2048x1536 · CFP · 45° FOV:
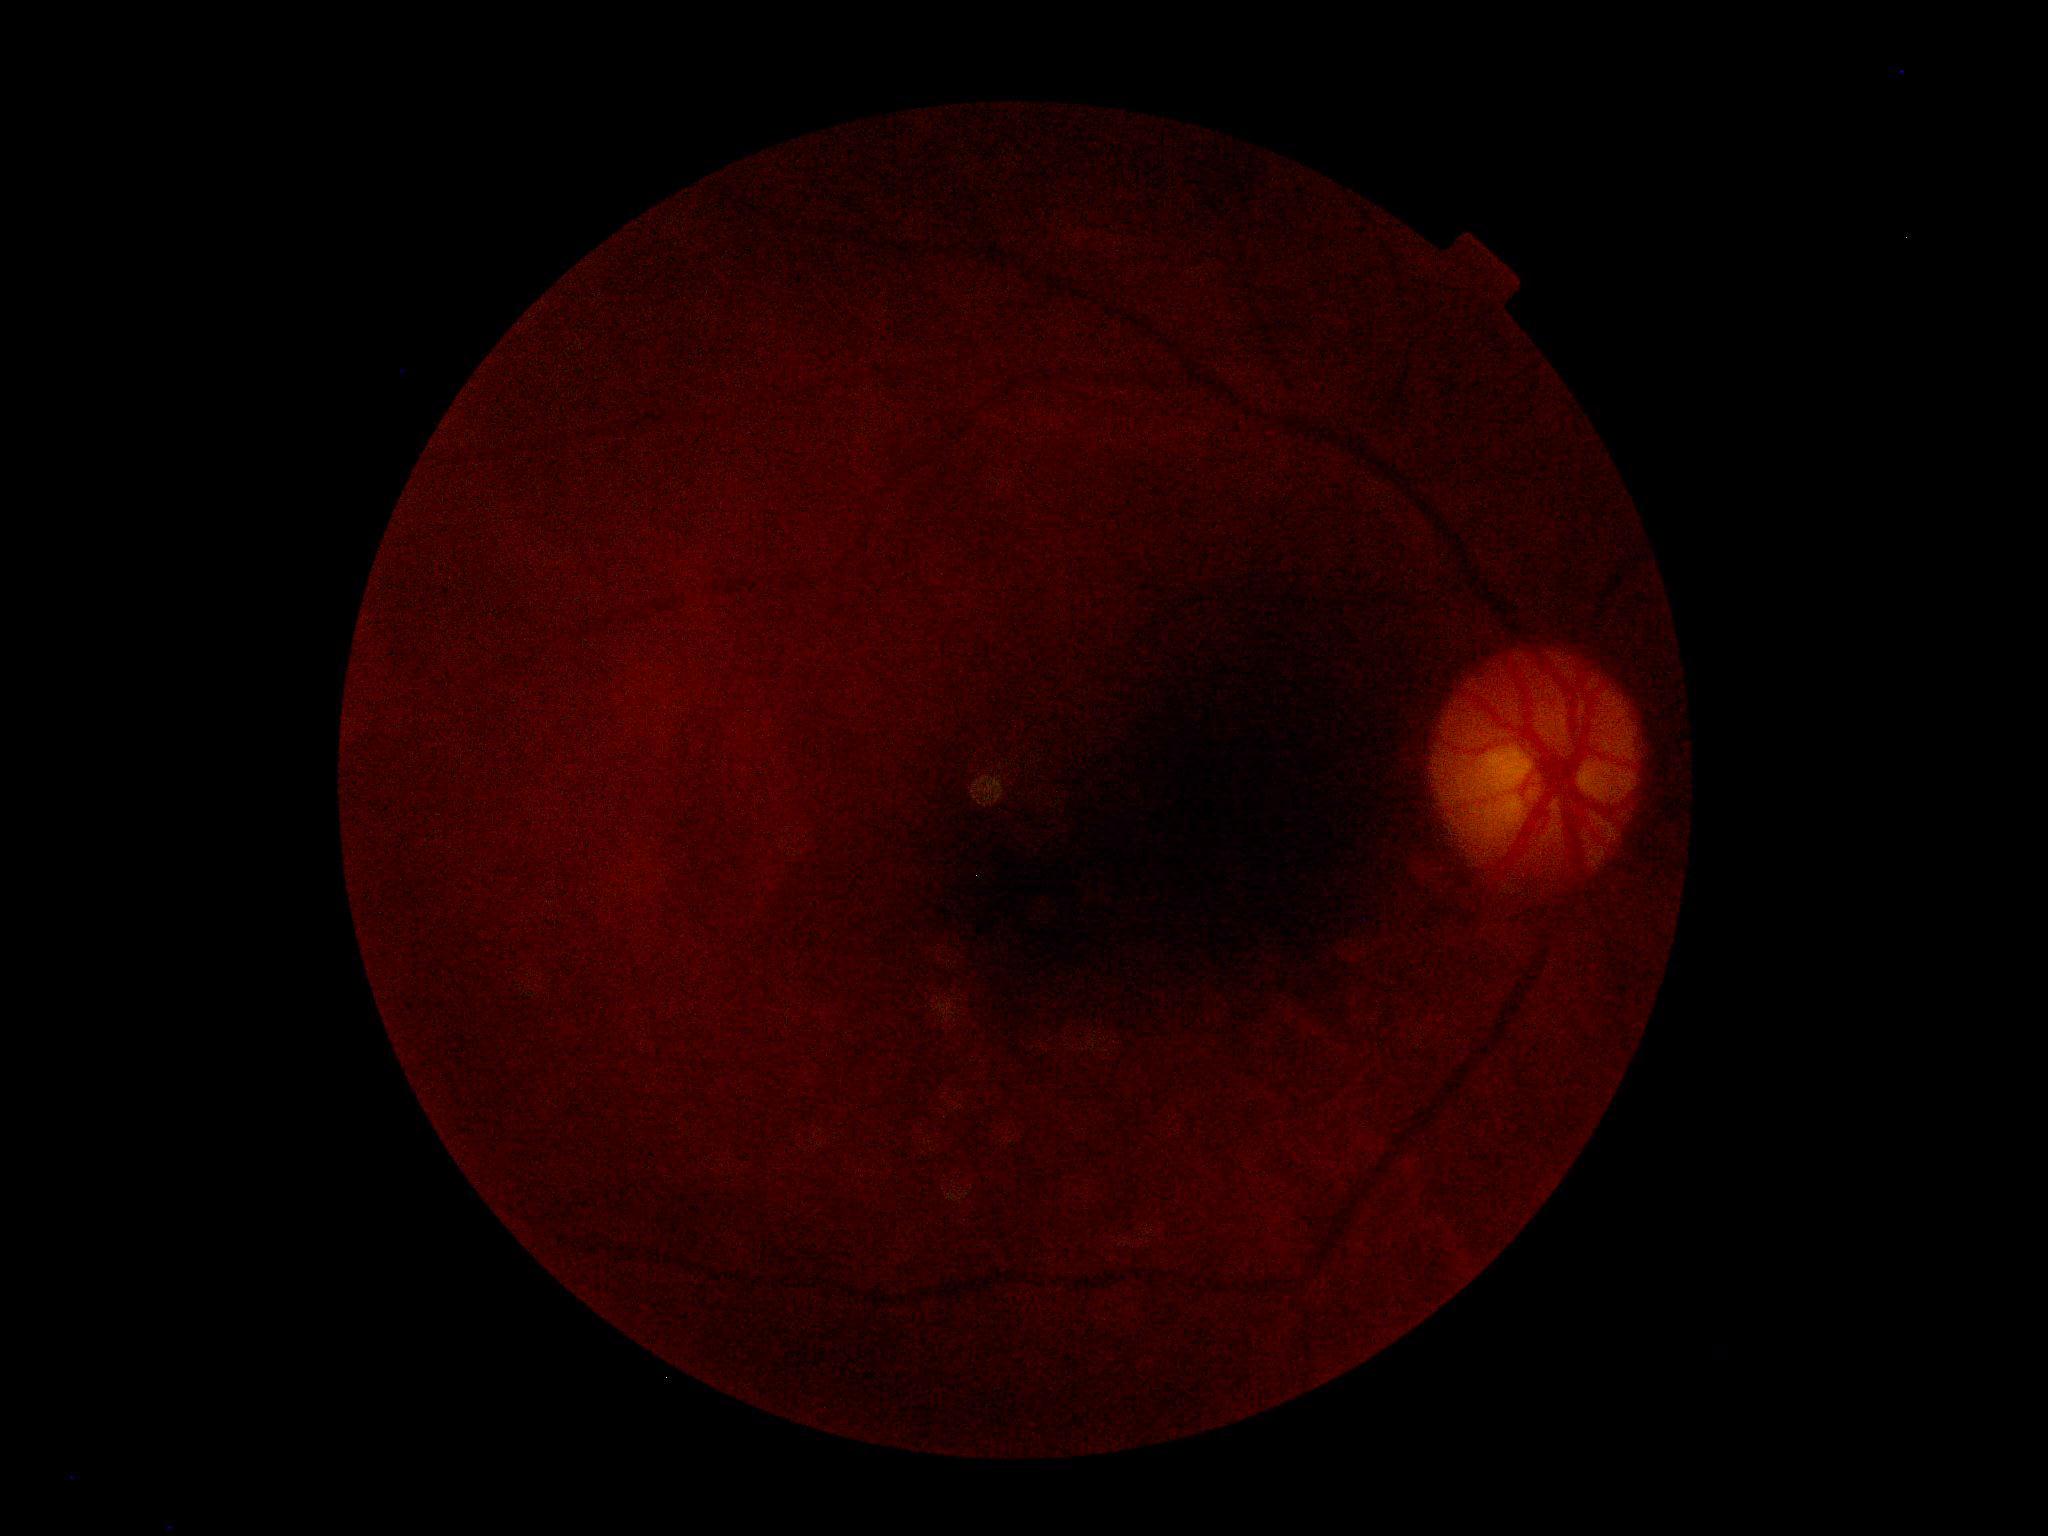
DR grade: ungradable; image quality: insufficient for DR assessment.